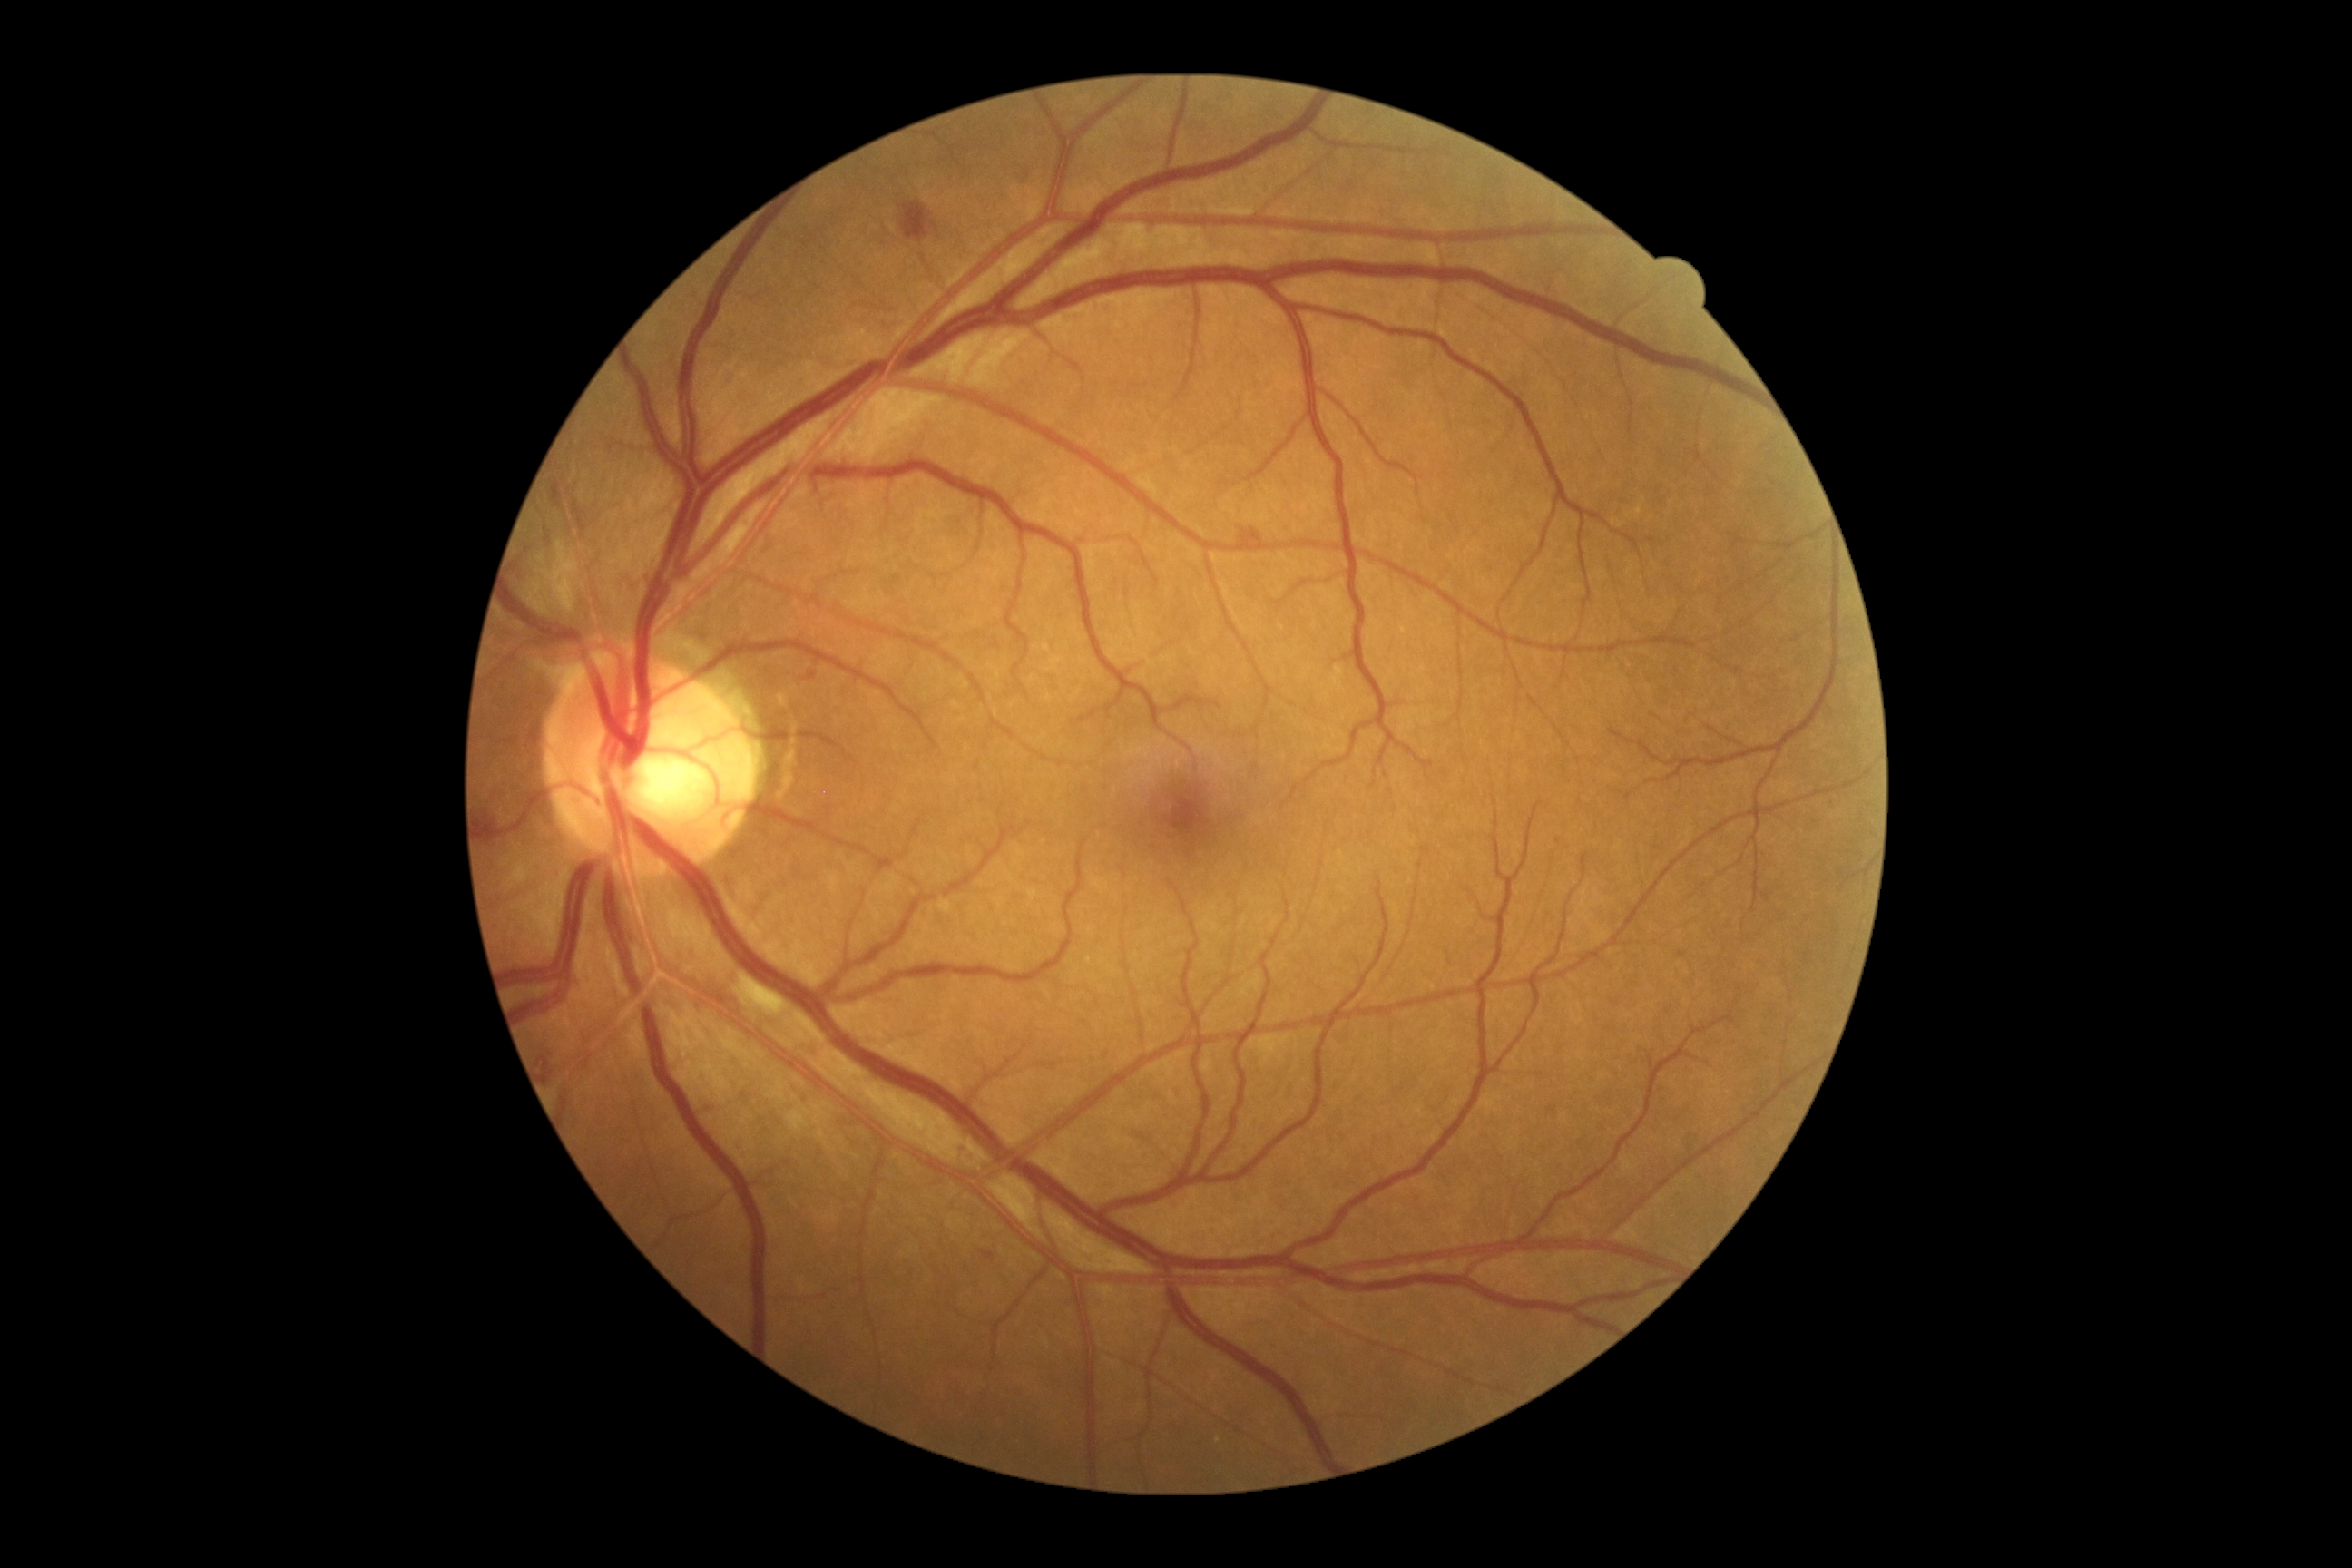

Diabetic retinopathy: 2 — more than just microaneurysms but less than severe NPDR.